NIDEK AFC-230 · retinal fundus photograph · 45 degree fundus photograph · 848 by 848 pixels
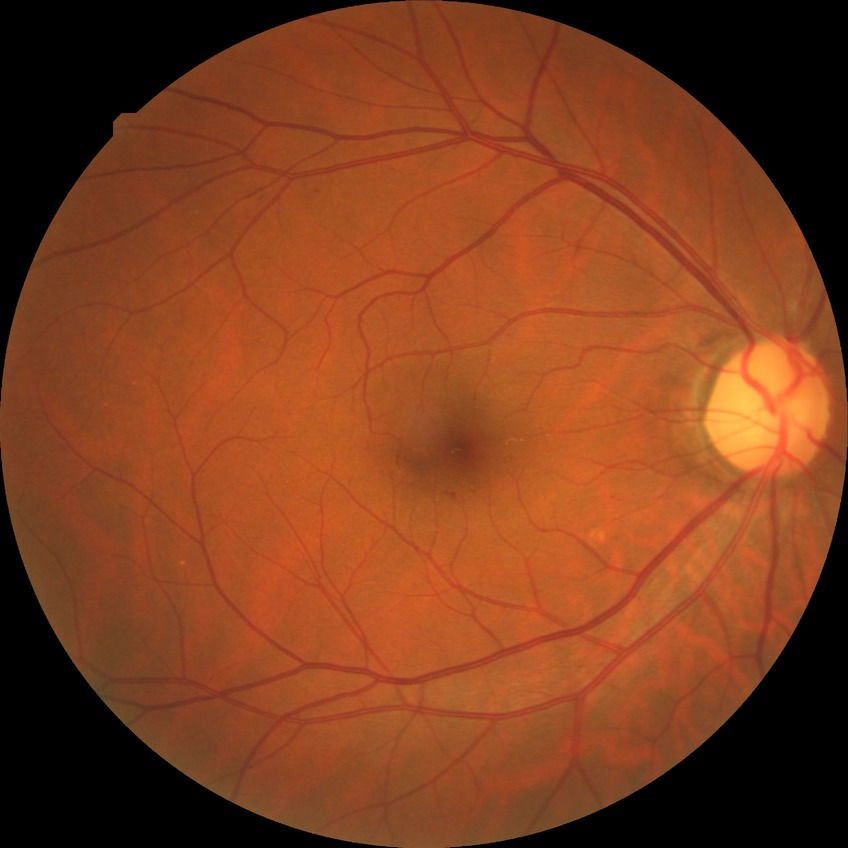 DR grade: SDR. DR class: non-proliferative diabetic retinopathy.